Posterior pole photograph · nonmydriatic fundus photograph · acquired with a NIDEK AFC-230 · 45 degree fundus photograph · 848 x 848 pixels.
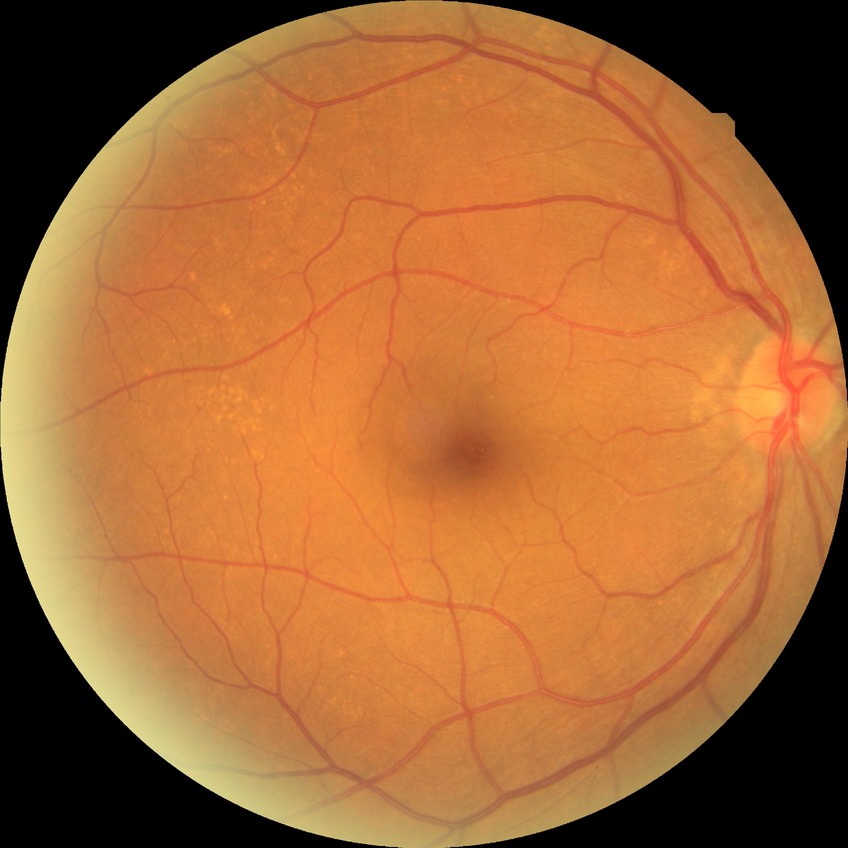 Diabetic retinopathy (DR) is no diabetic retinopathy (NDR).